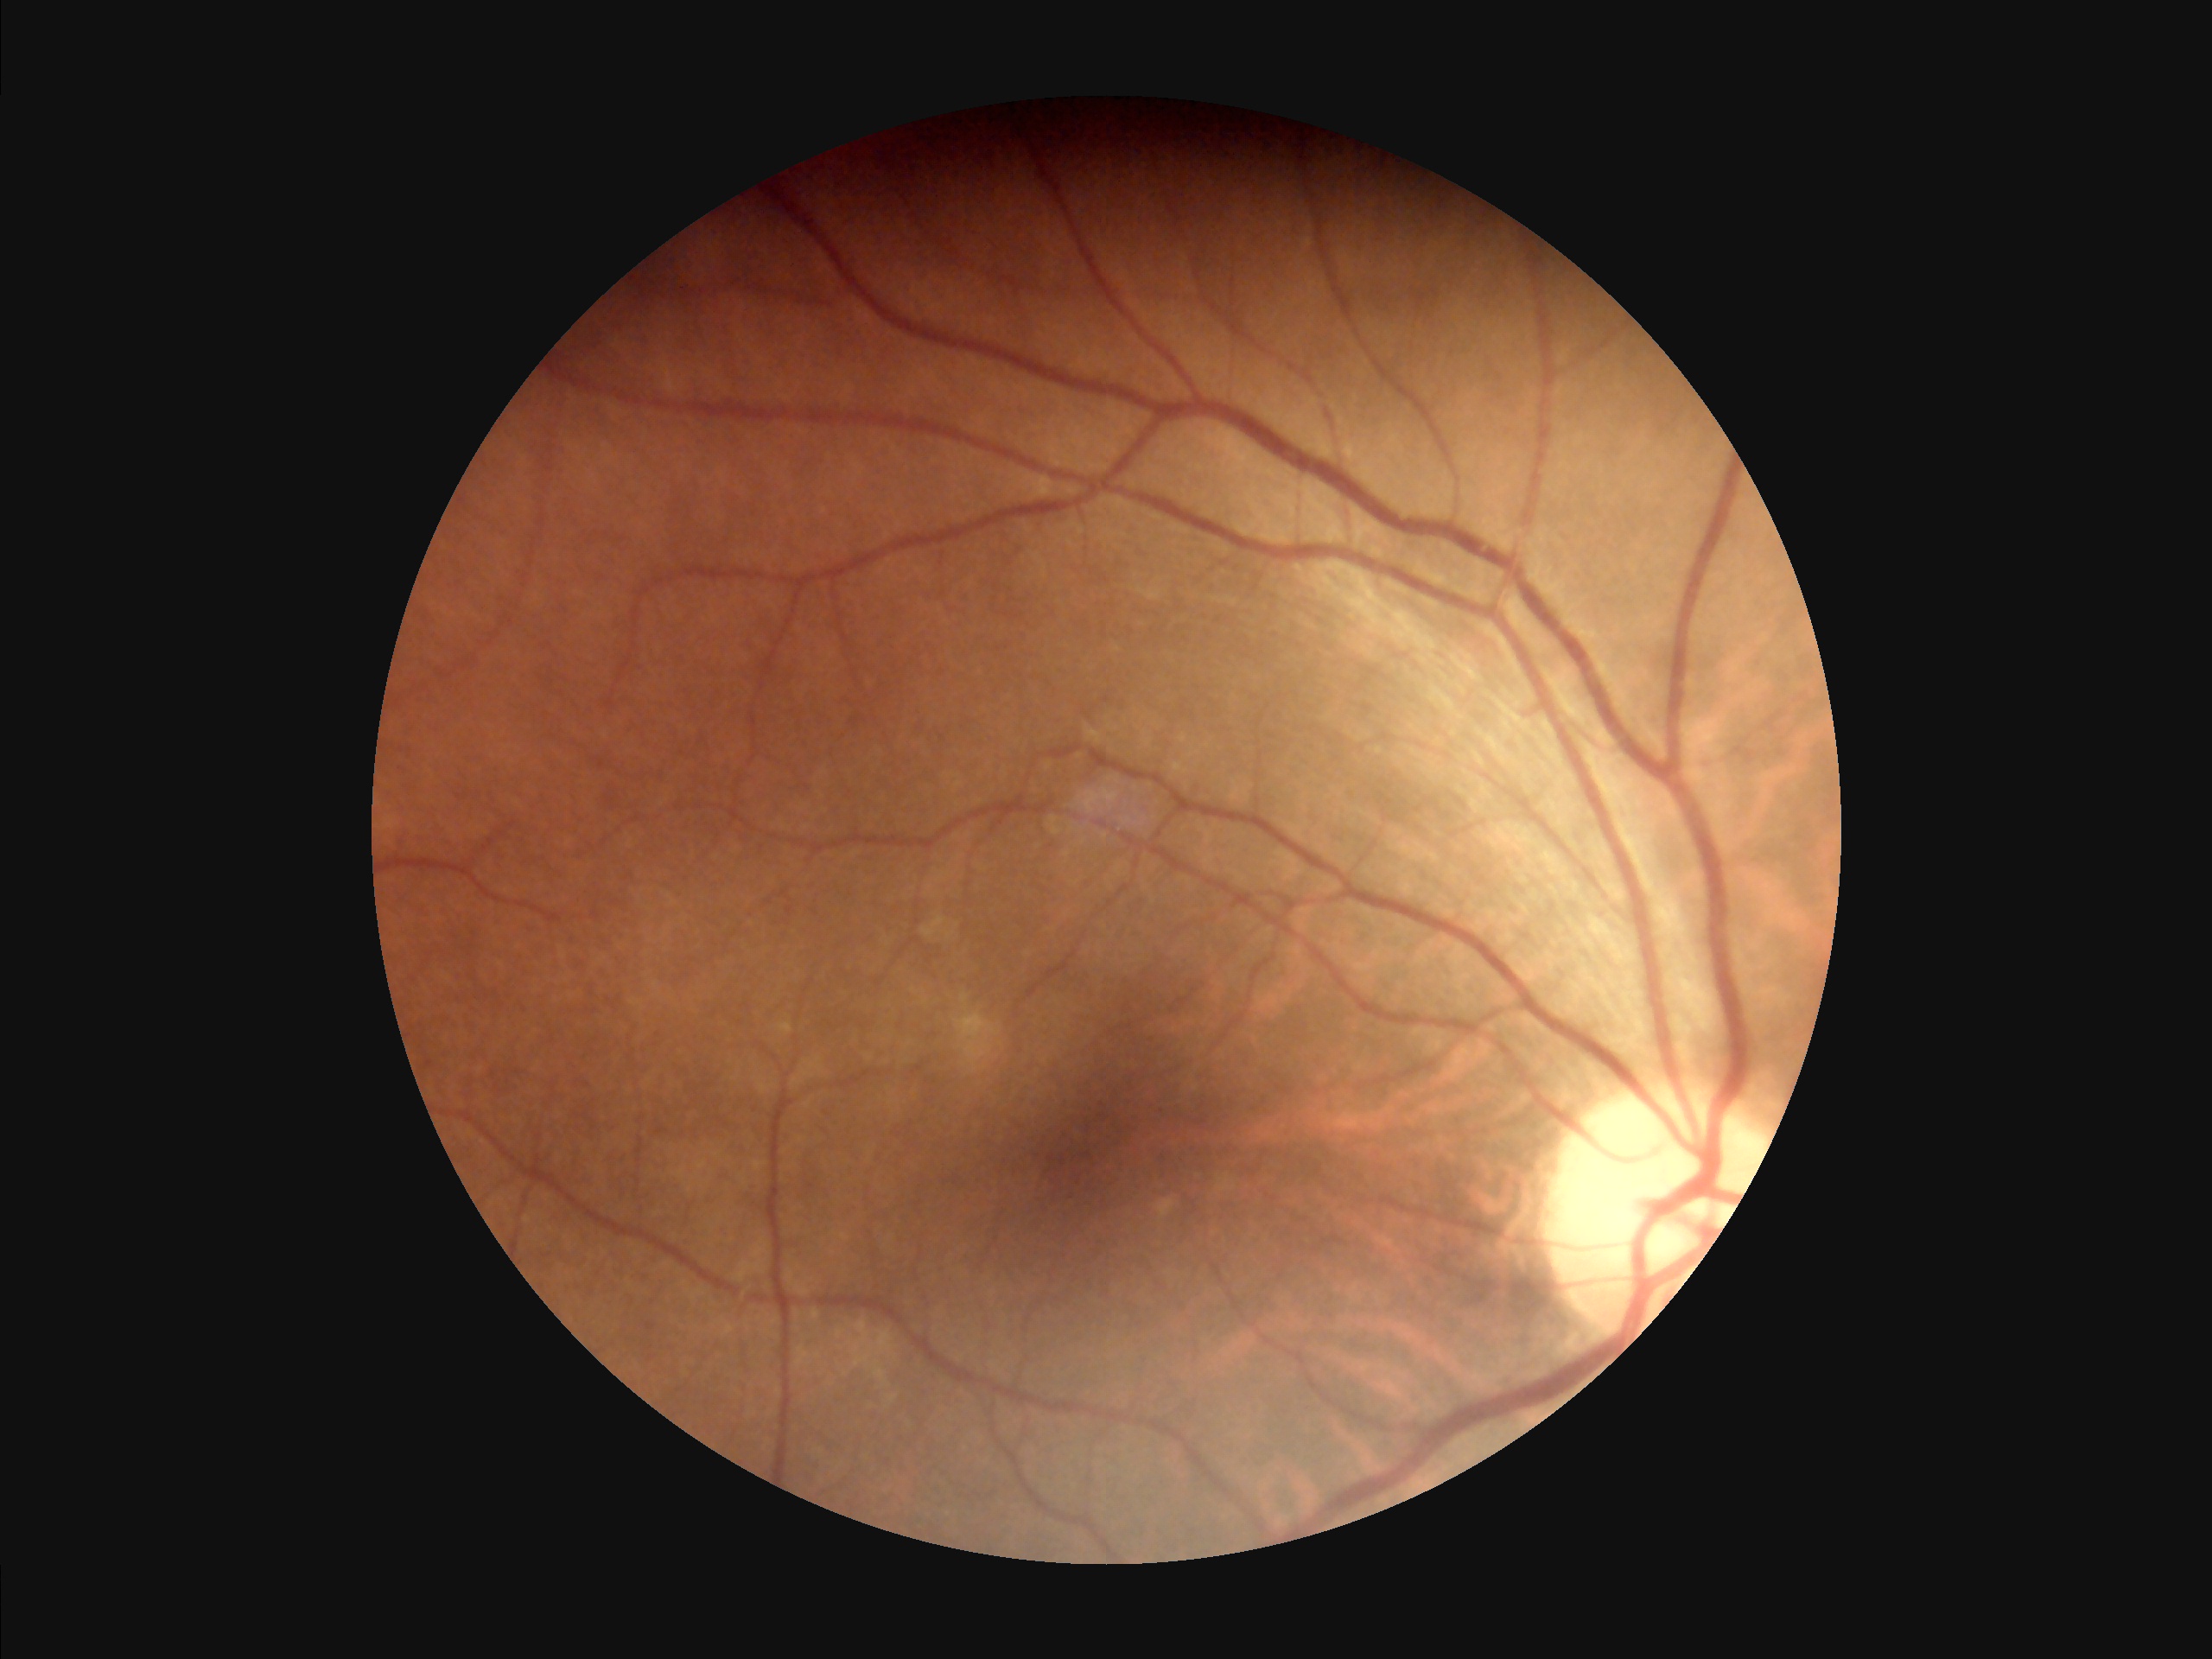

Vessels and details are readily distinguishable. Overall quality is good and the image is gradable. Image is sharp throughout the field.